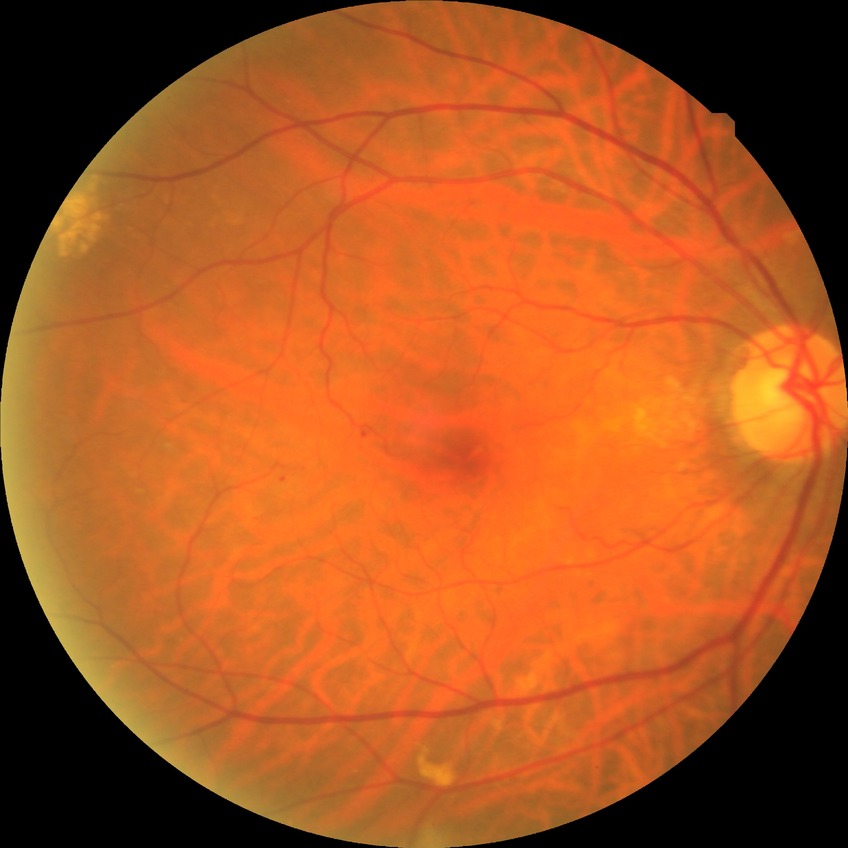 Diabetic retinopathy grade is no diabetic retinopathy.